Phoenix ICON wide-field infant fundus image · 100° field of view (Phoenix ICON) · 1240 x 1240 pixels — 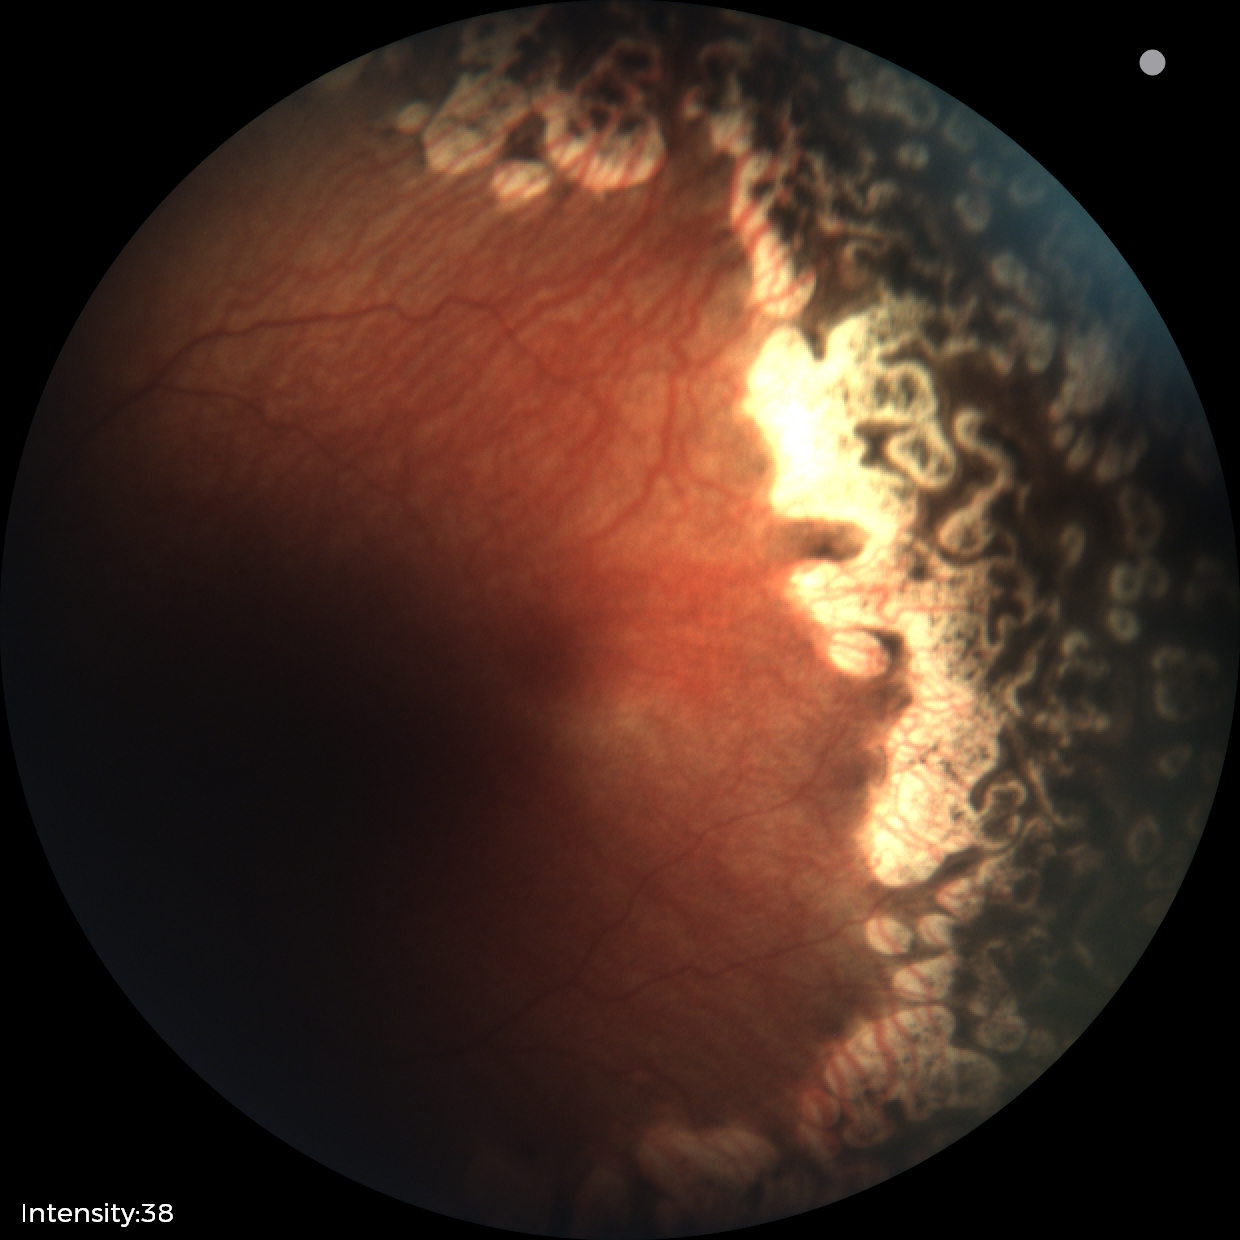

Finding: status post ROP | plus form: absent.